Retinal fundus photograph; 45° field of view; 1932 by 1916 pixels — 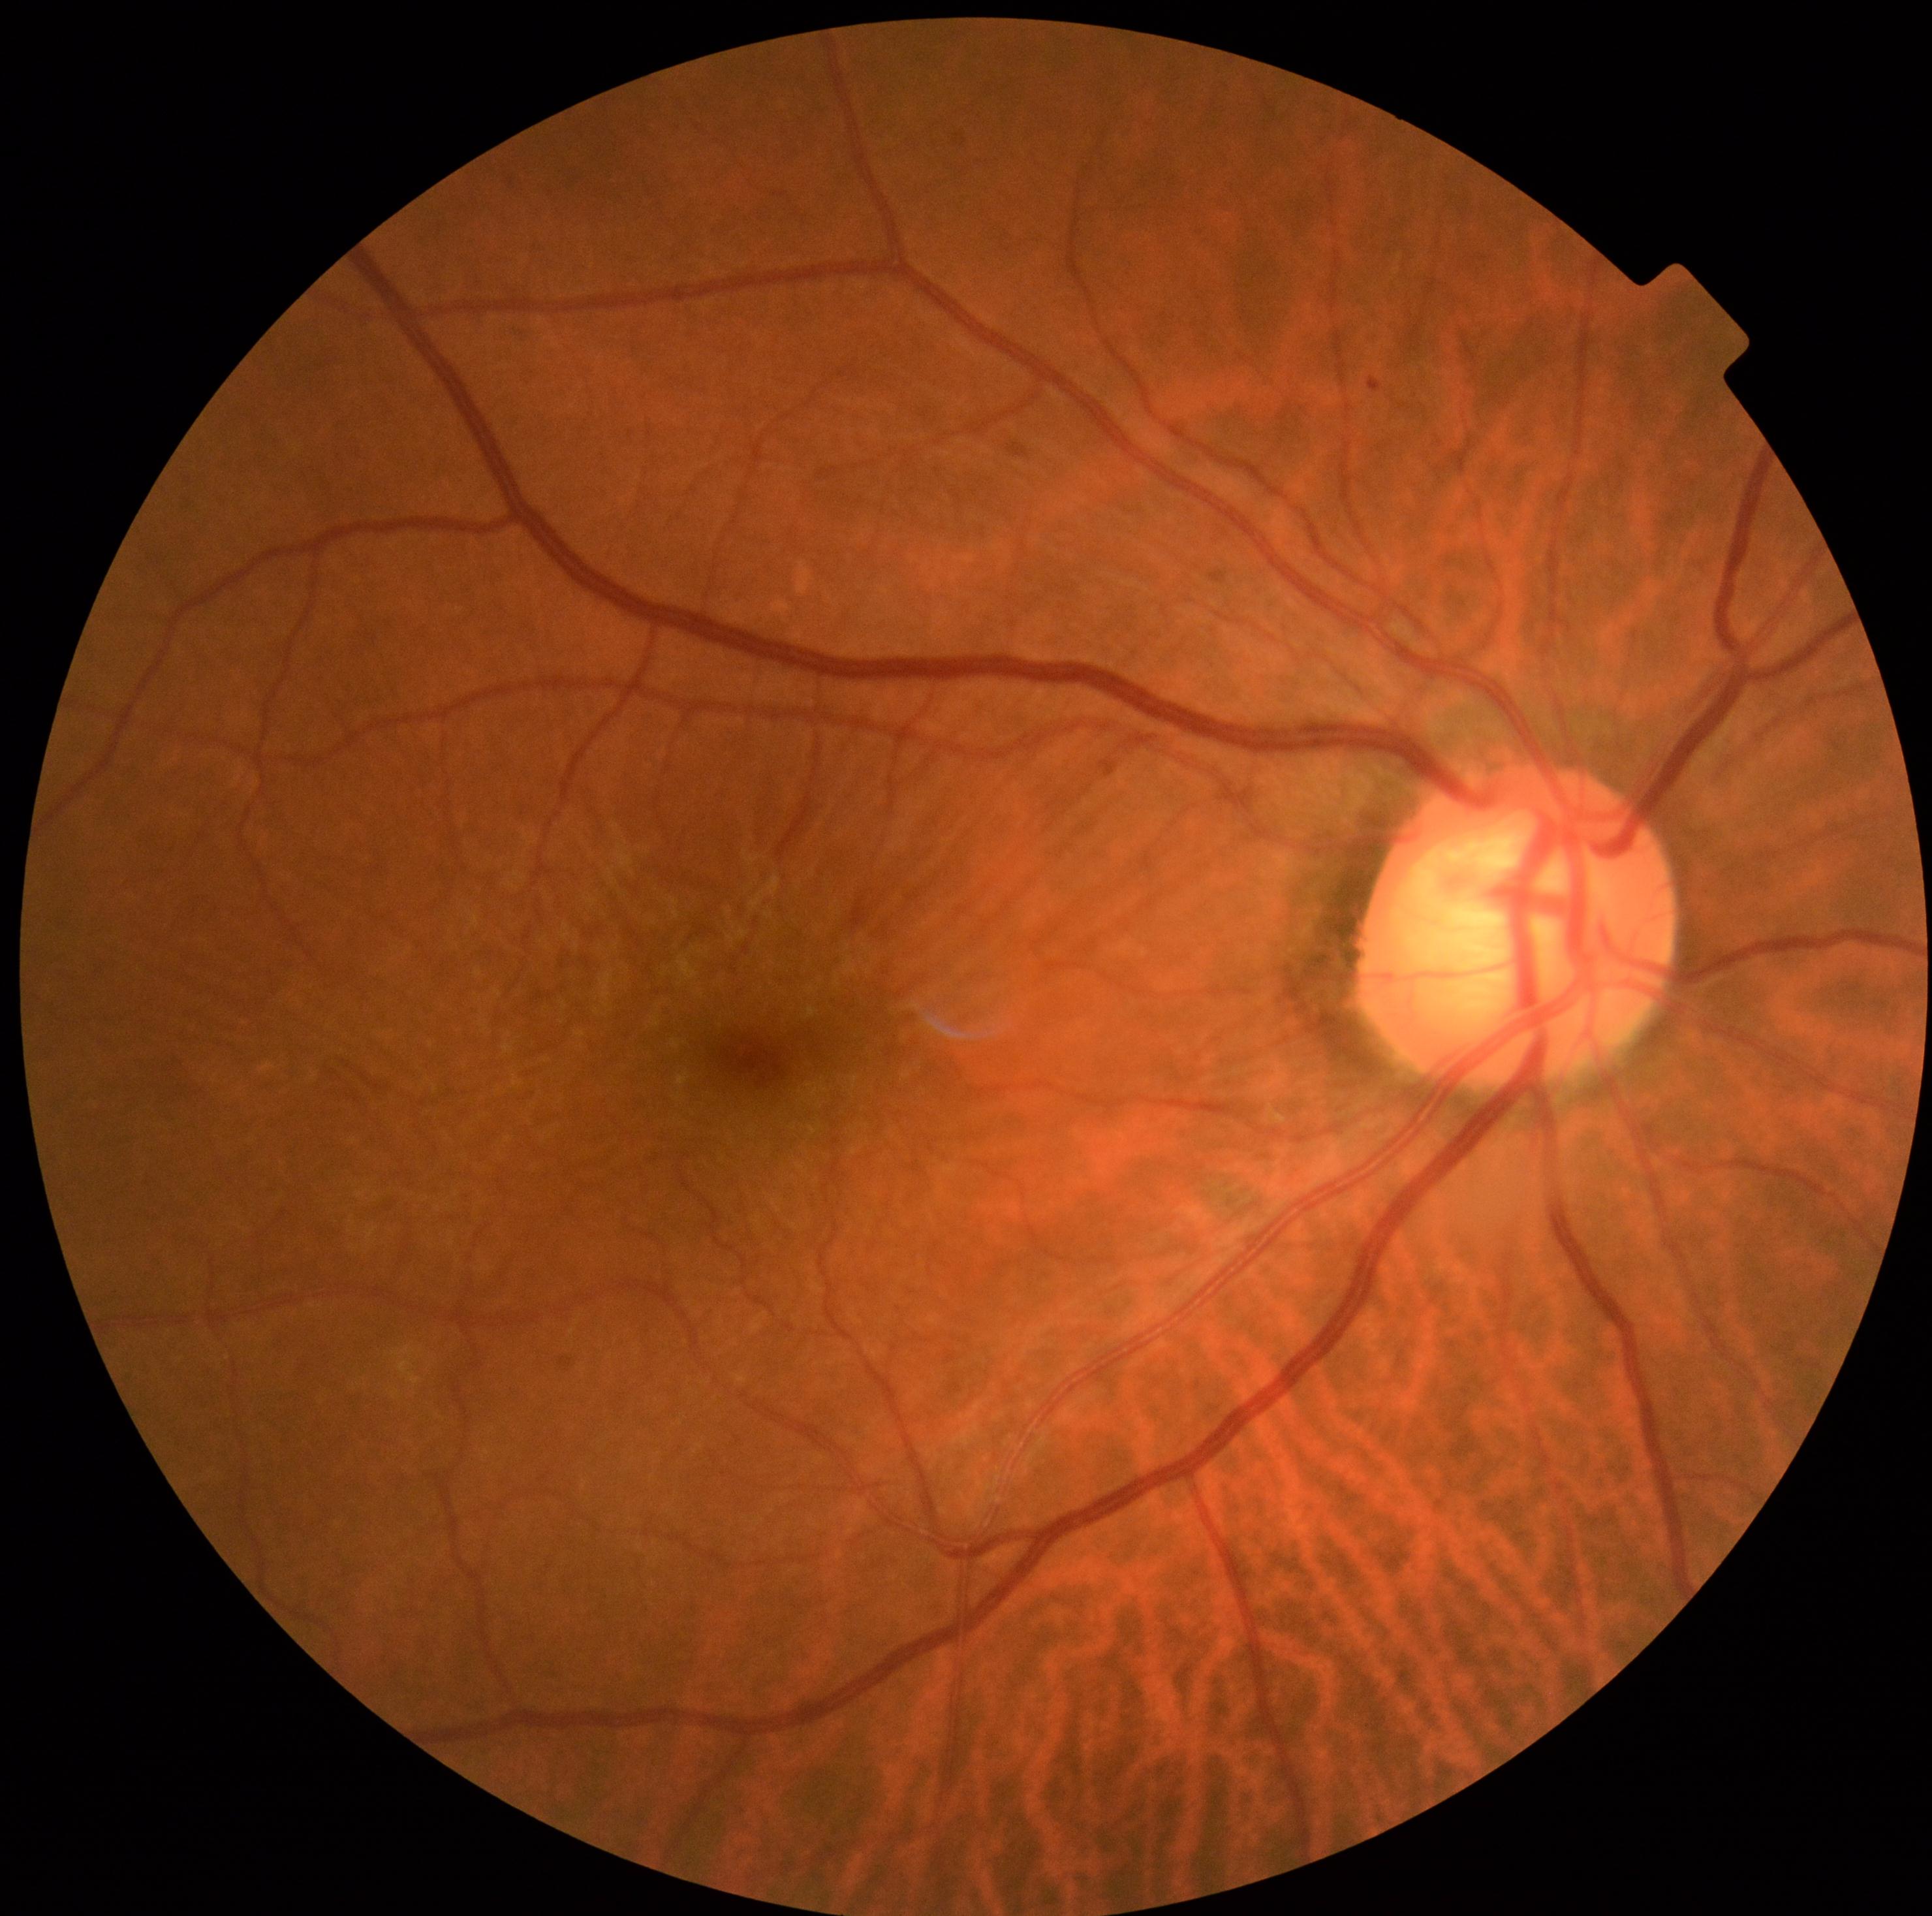
DR severity@1.